Diabetic retinopathy graded by the modified Davis classification, nonmydriatic fundus photograph:
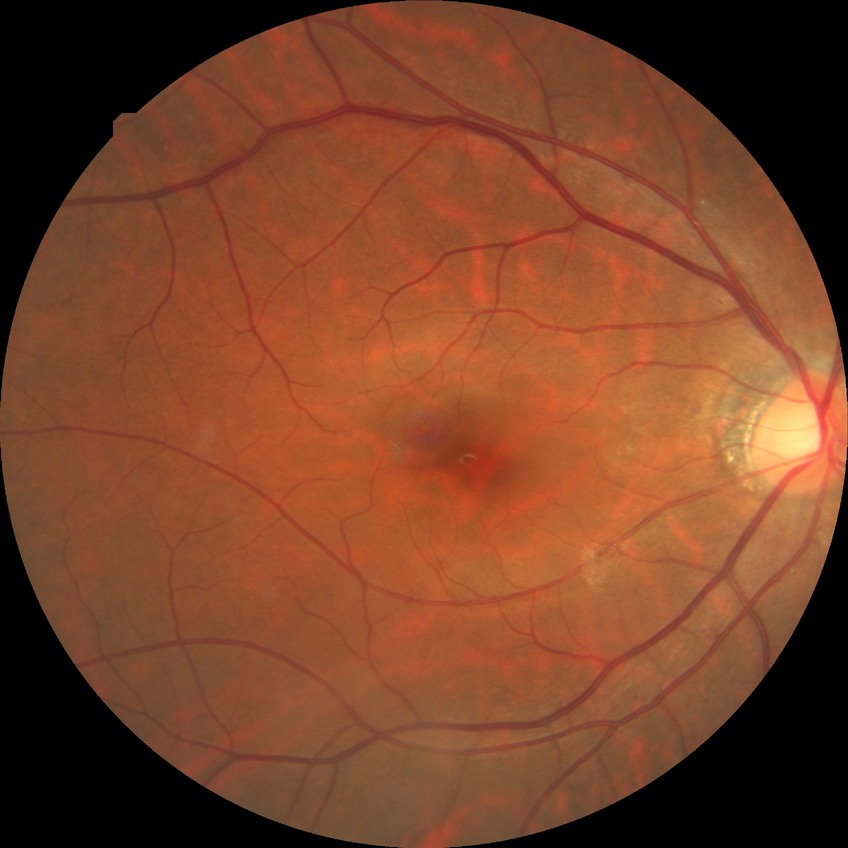
Diabetic retinopathy (DR) is NDR (no diabetic retinopathy).